Non-mydriatic fundus camera, retinal fundus photograph: 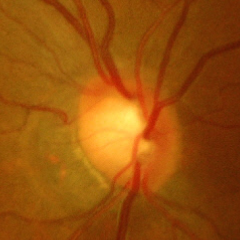

Q: Is glaucoma present?
A: Yes — advanced-stage glaucoma.